Retinal fundus photograph. 50-degree field of view: 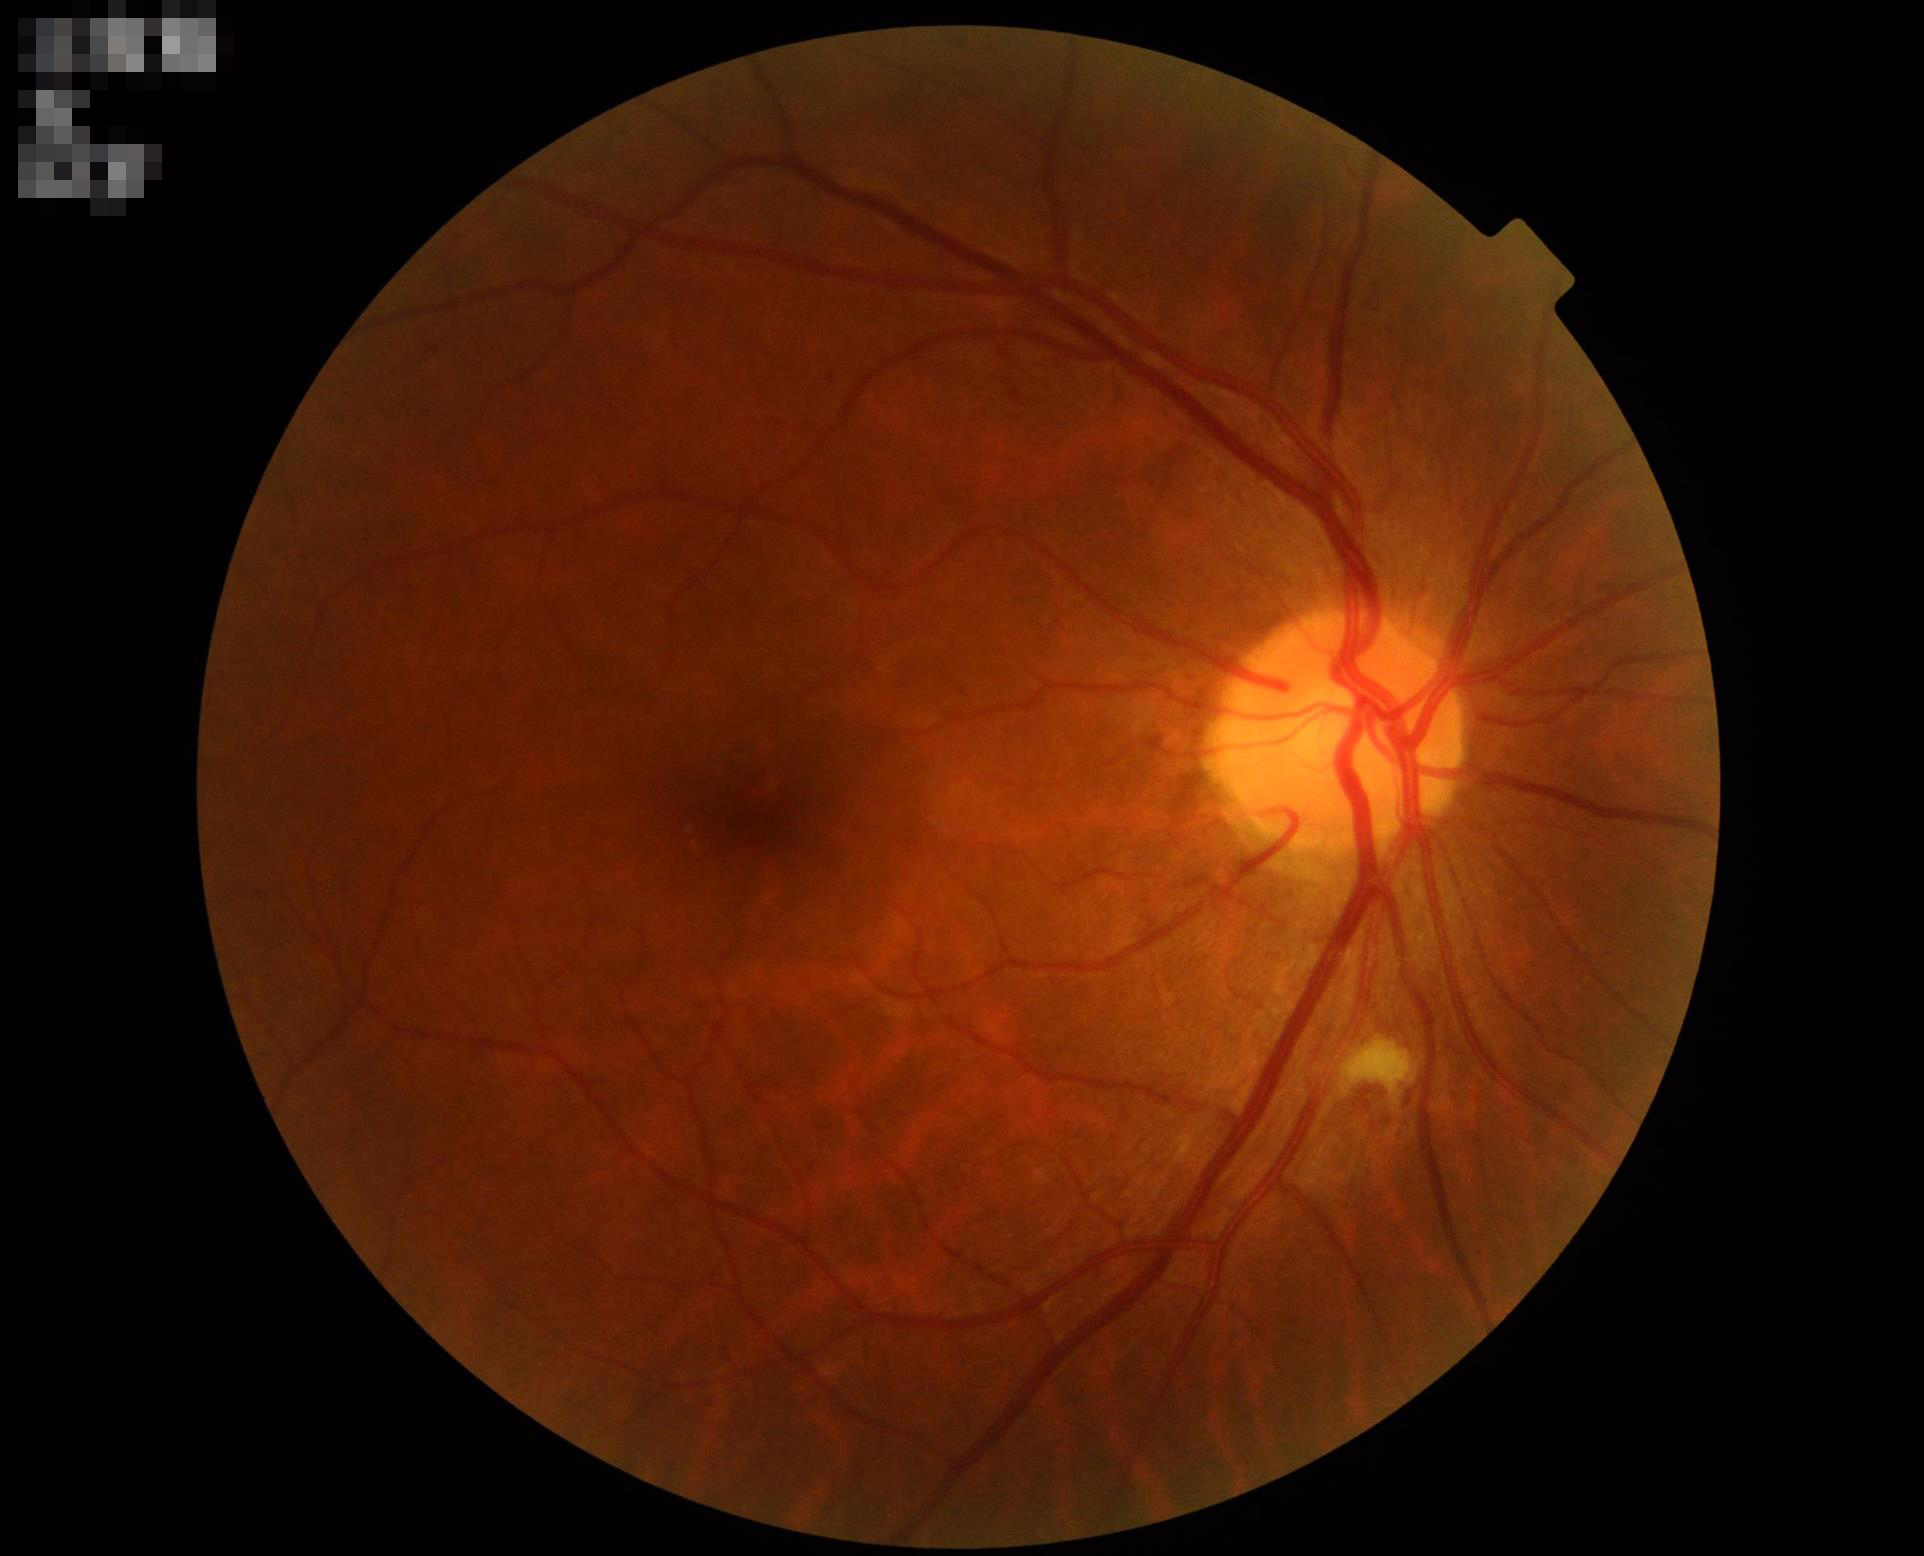
overall_quality: adequate
clarity: in focus
contrast: good